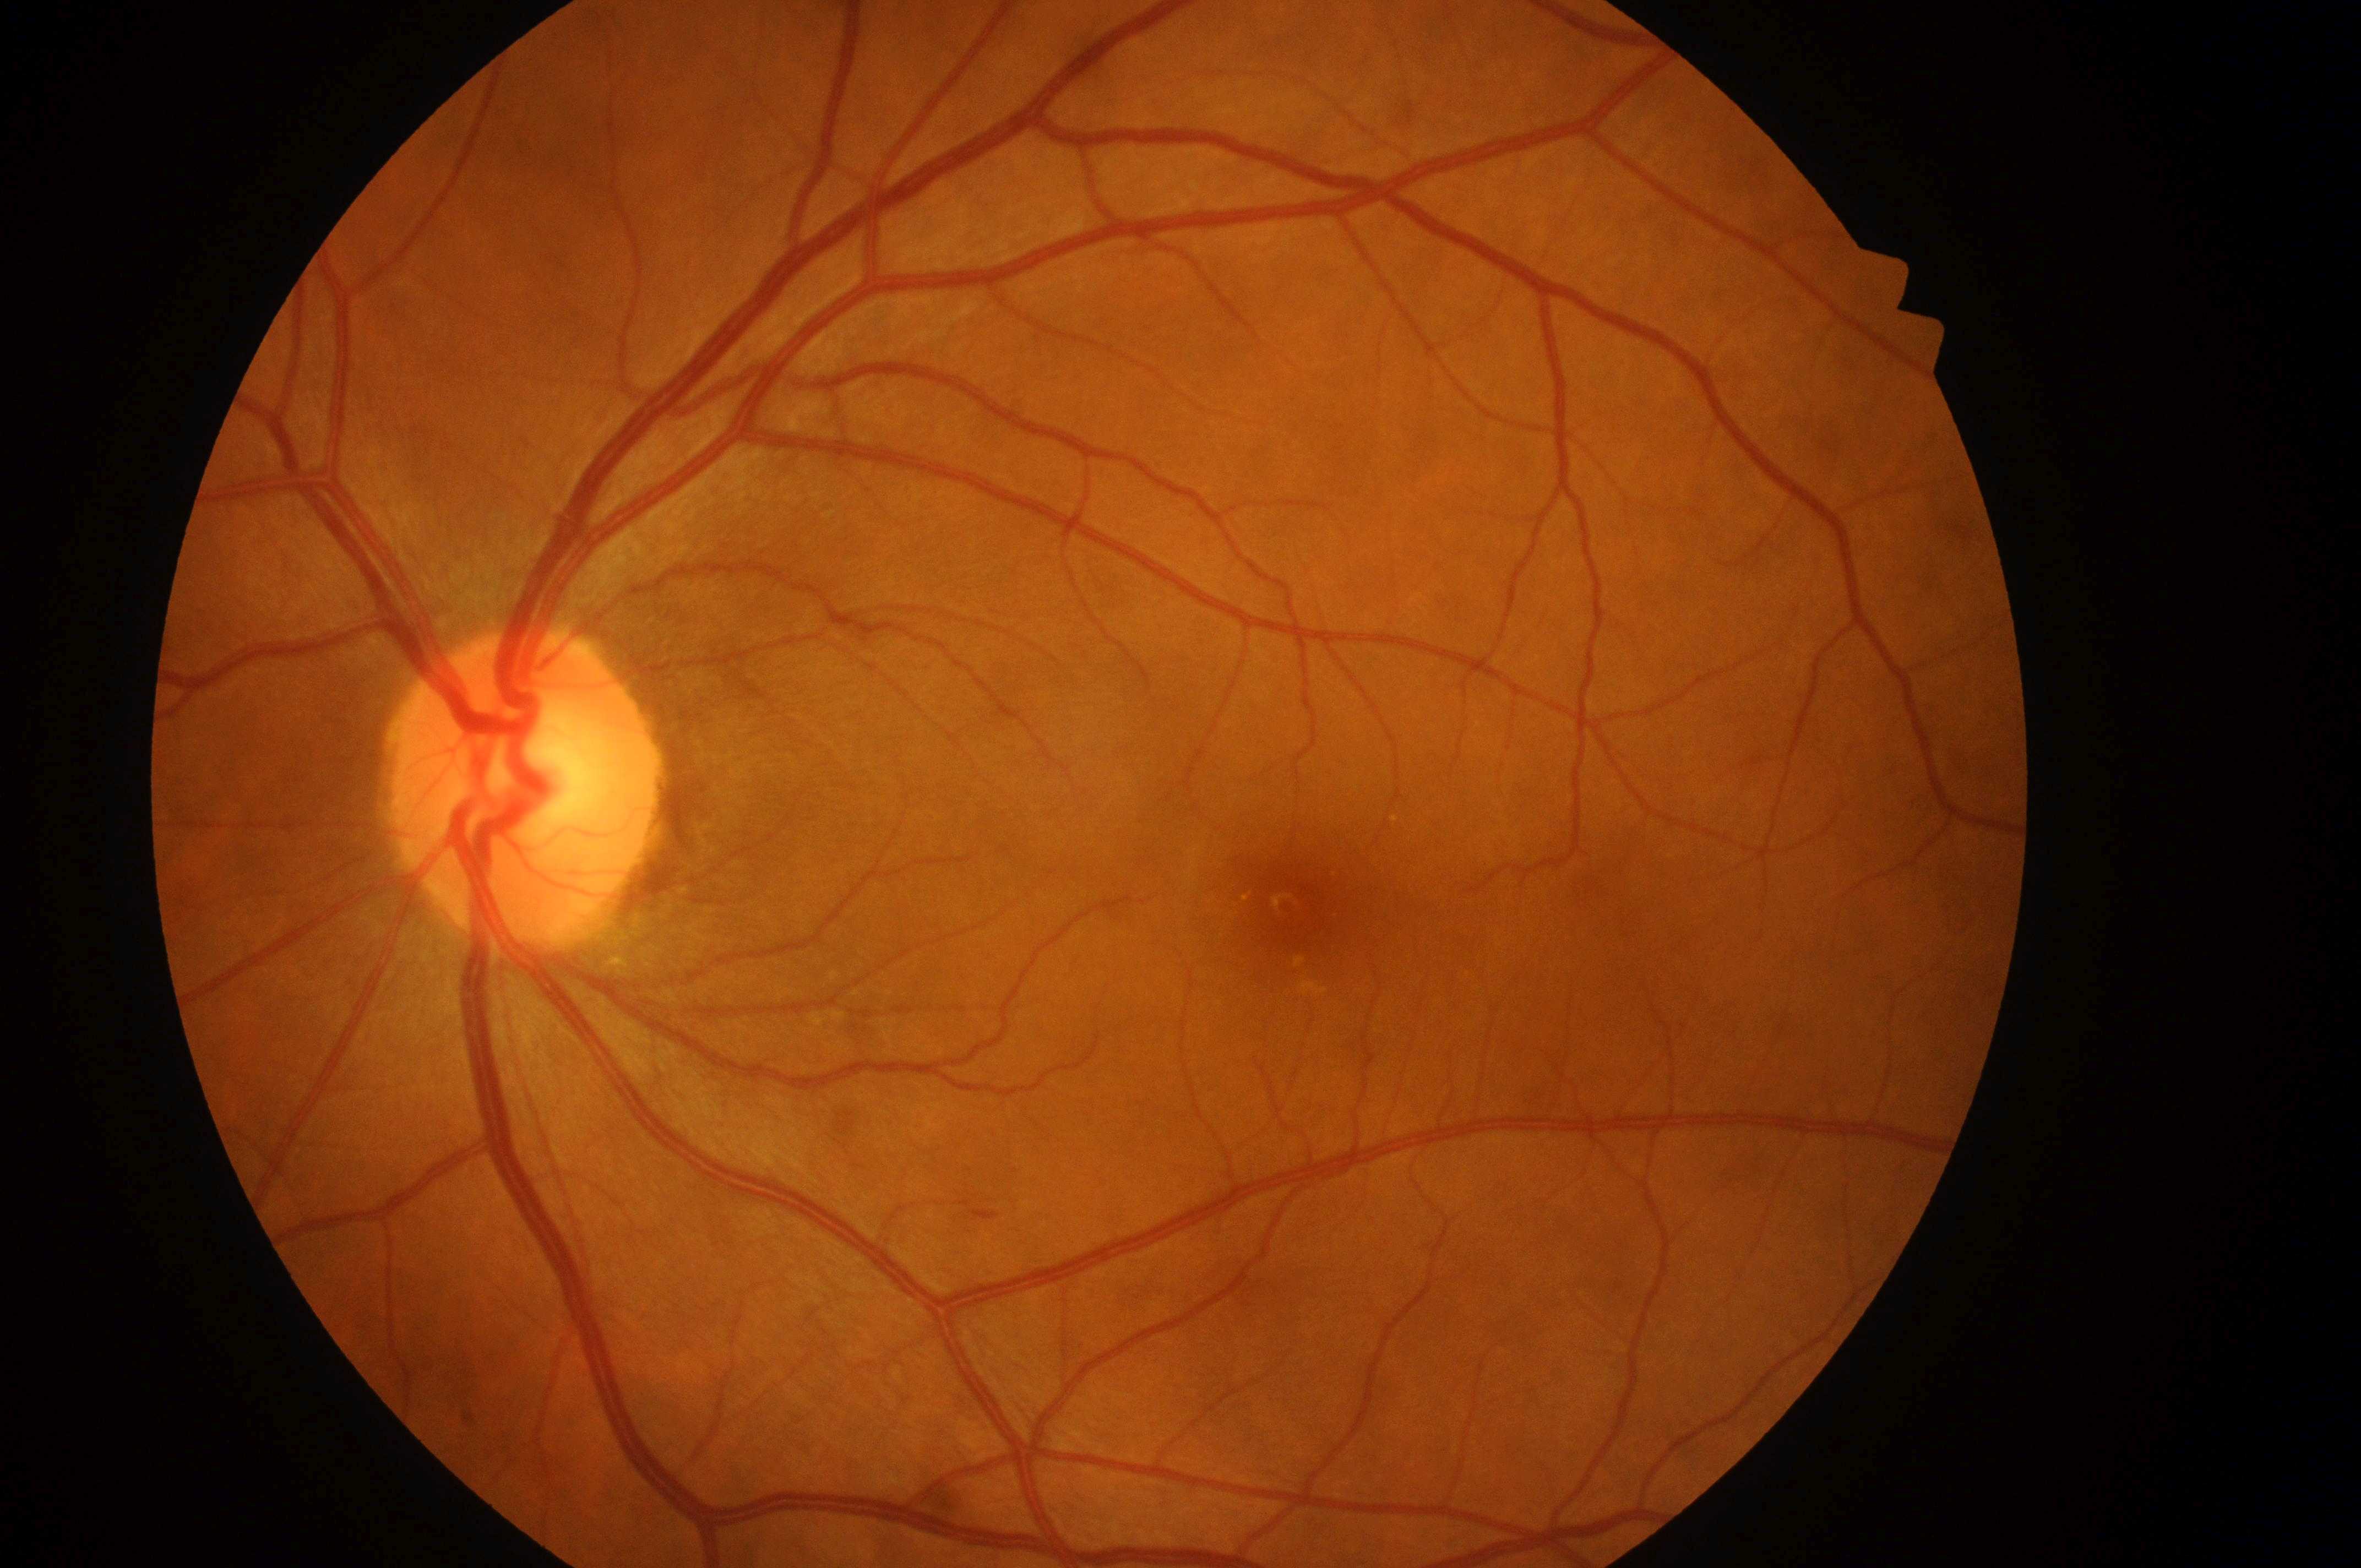
laterality = left; DR stage = grade 2 — more than just microaneurysms but less than severe NPDR; macula center = [1303, 905]; the optic disc = [513, 798]; DME risk = 2 — hard exudates within one disc diameter of the macula center.